1659x2212. CFP
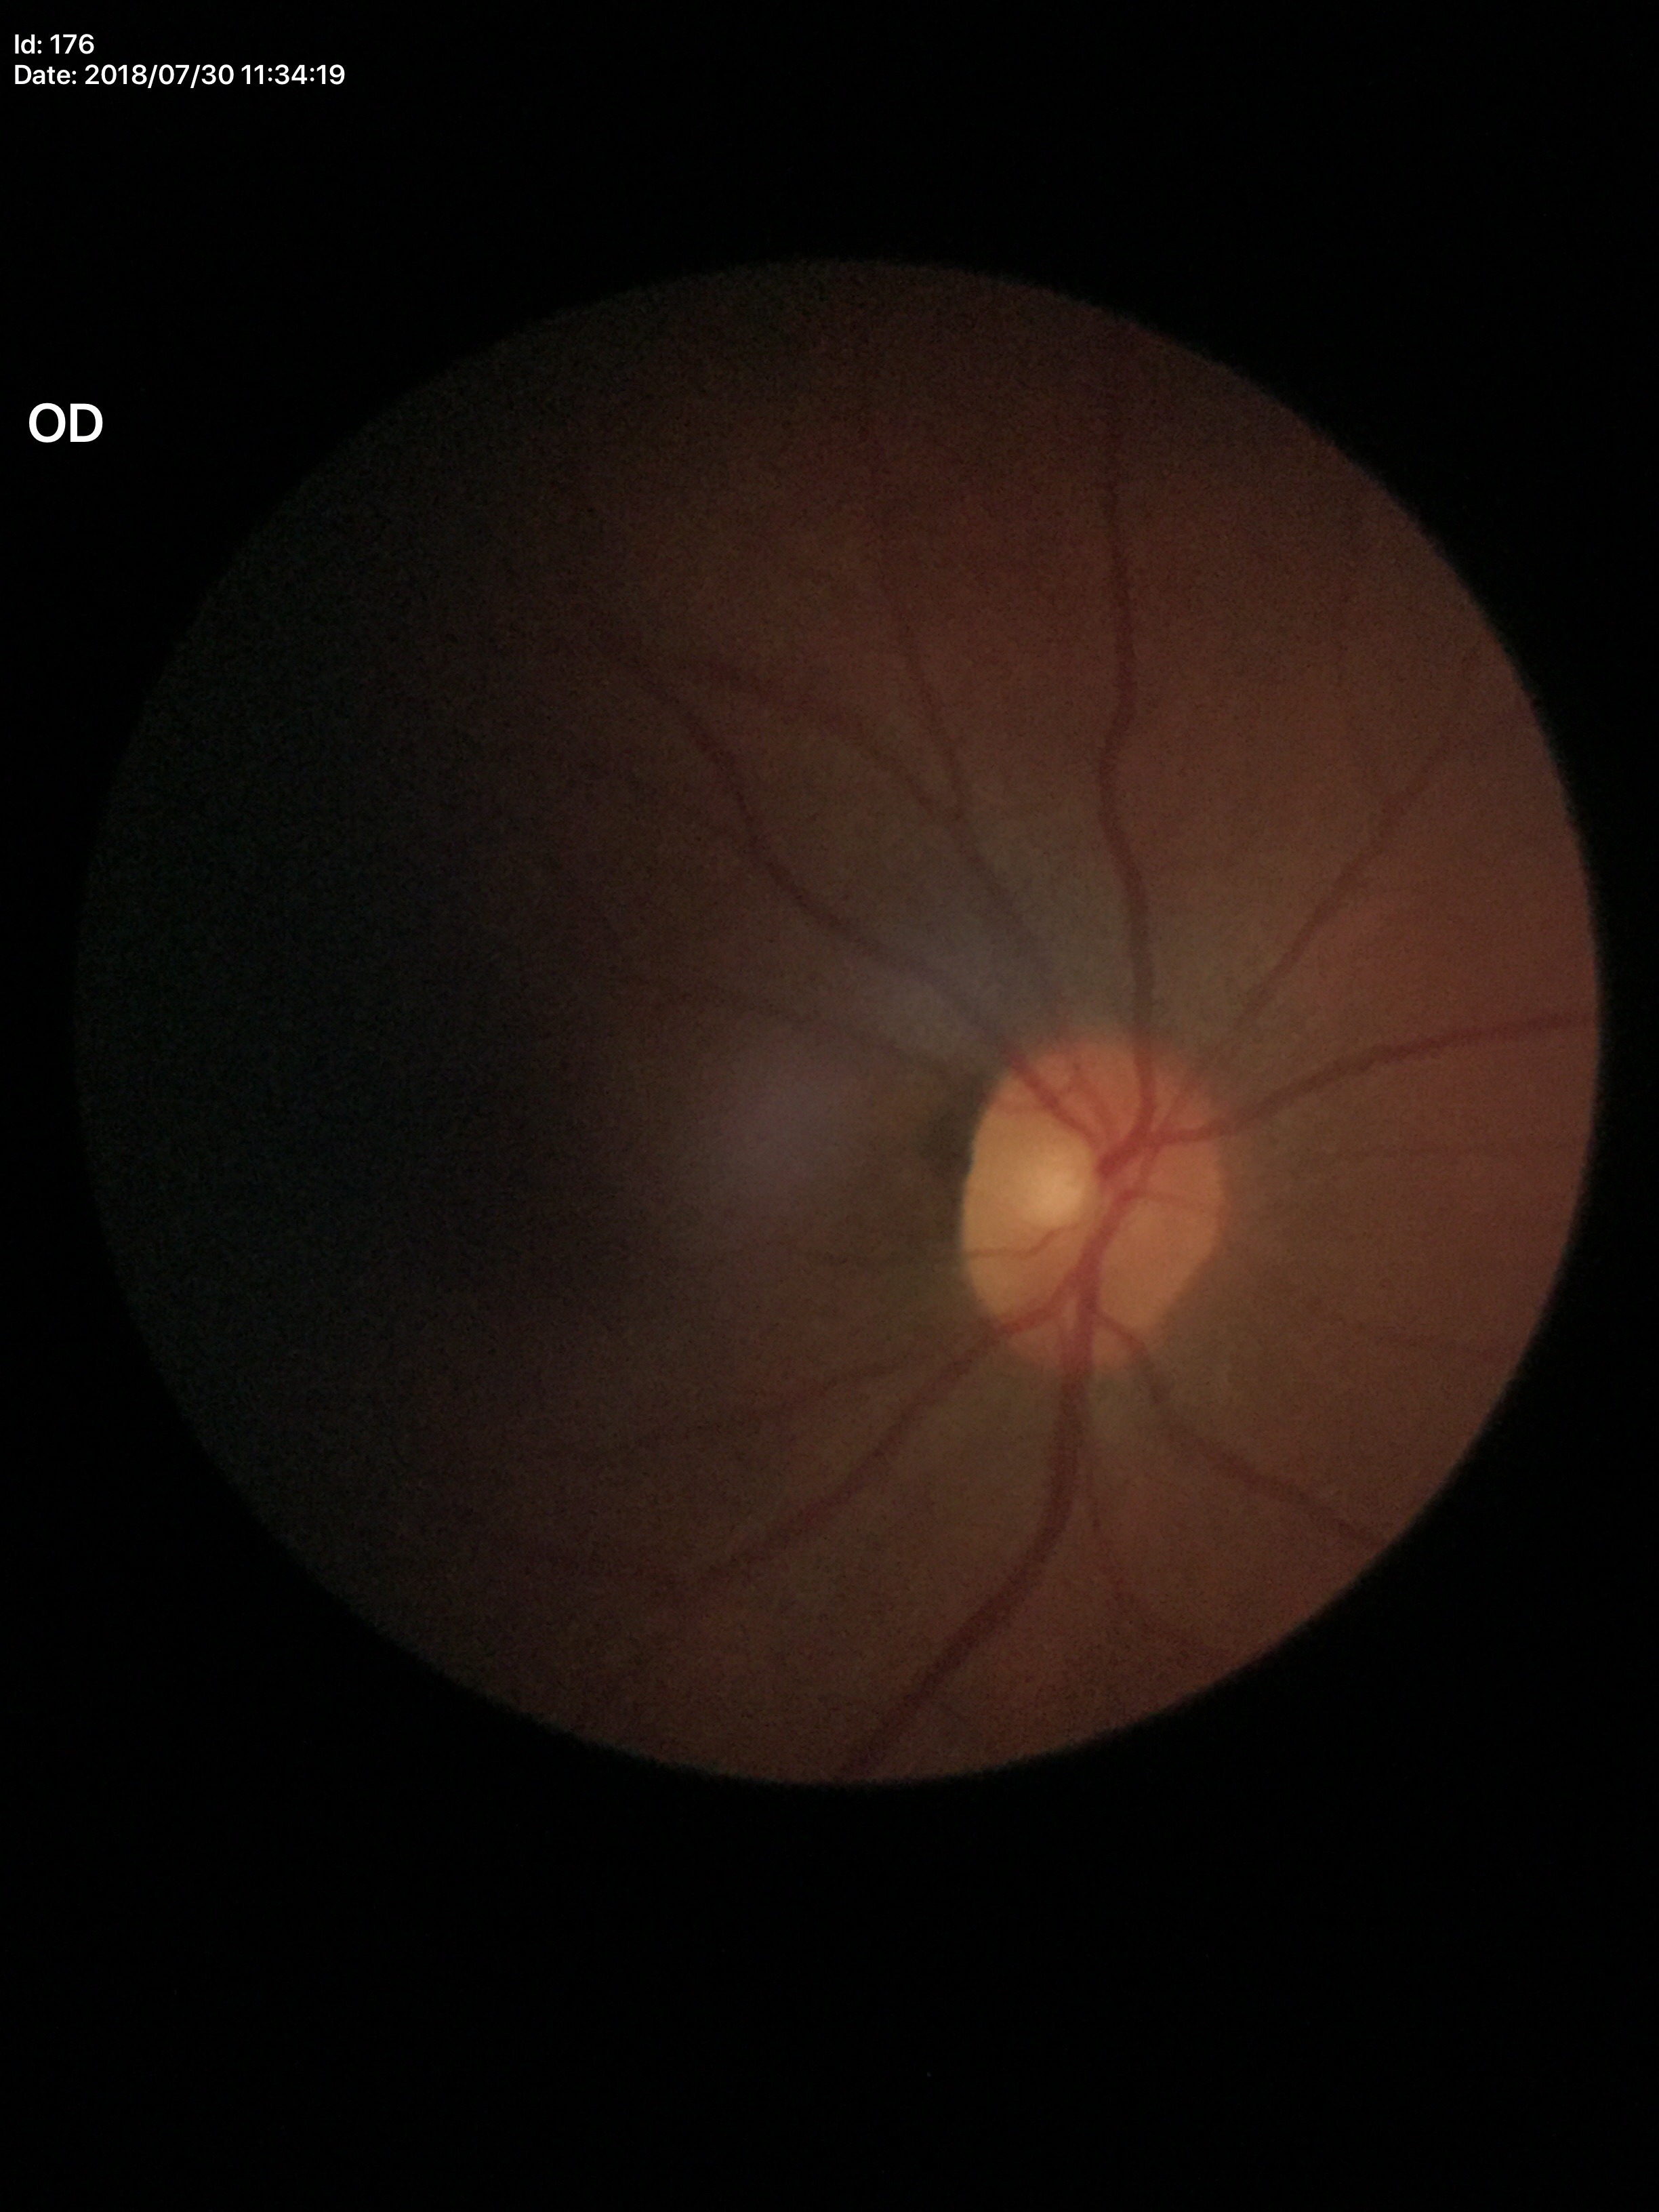
Glaucoma screening: not suspect (5/5 ophthalmologists in agreement). Vertical CDR of 0.45. Horizontal C/D ratio is 0.46.